Pediatric wide-field fundus photograph; 1240x1240px; Phoenix ICON, 100° FOV.
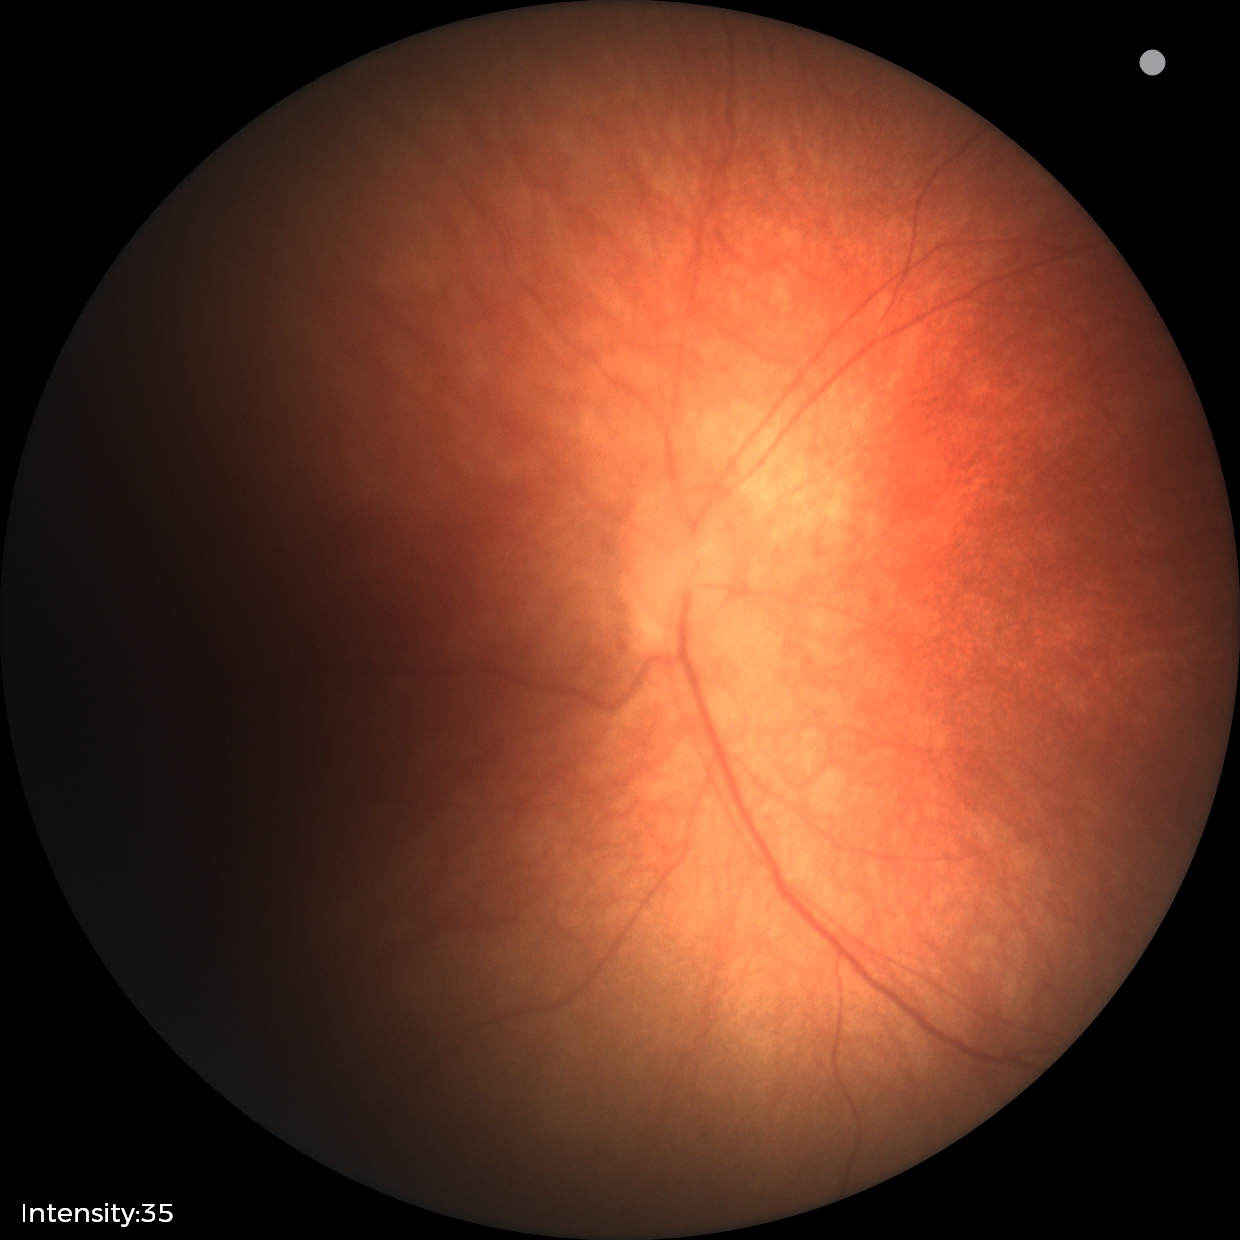
Impression: physiological retinal finding.